Davis DR grading.
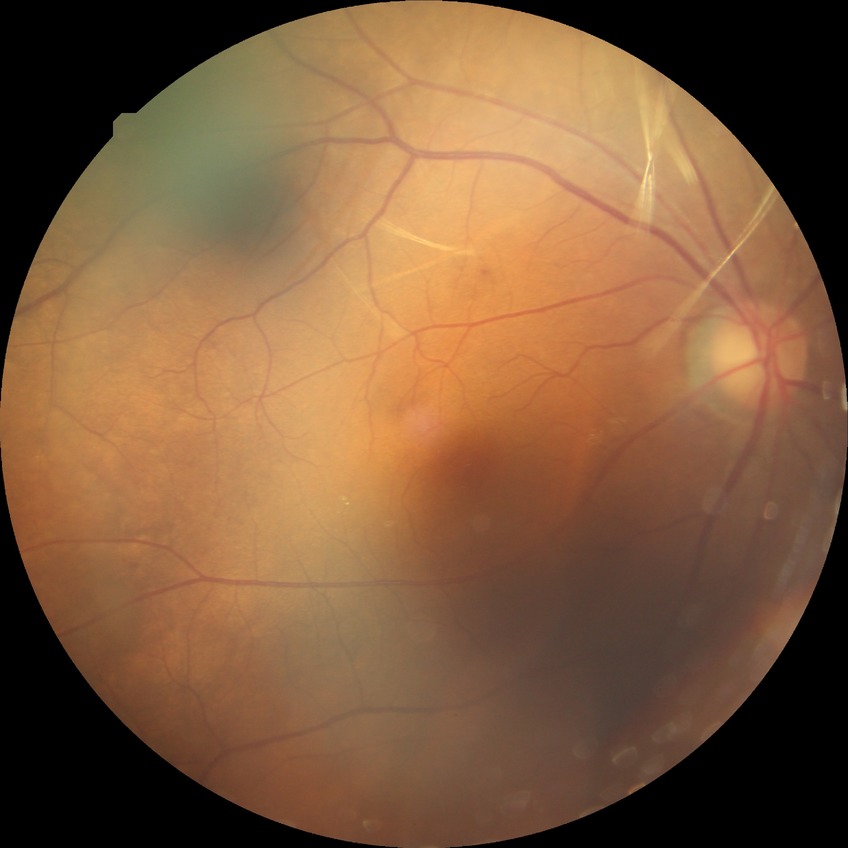

Diabetic retinopathy (DR): NDR (no diabetic retinopathy).